Tabletop color fundus camera image; image size 555x419 — 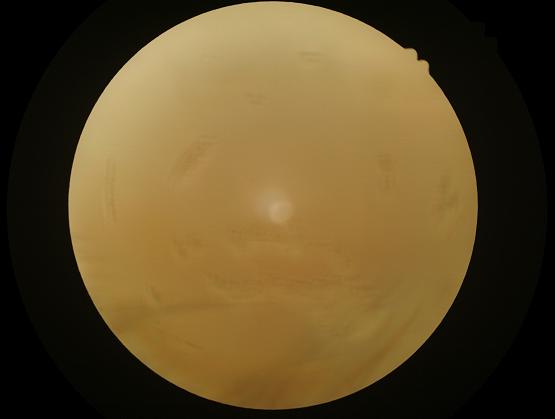 {
  "clarity": "out of focus",
  "overall_quality": "inadequate",
  "illumination": "uneven",
  "contrast": "low"
}